Acquired with a NIDEK AFC-230 · image size 848x848 · DR severity per modified Davis staging
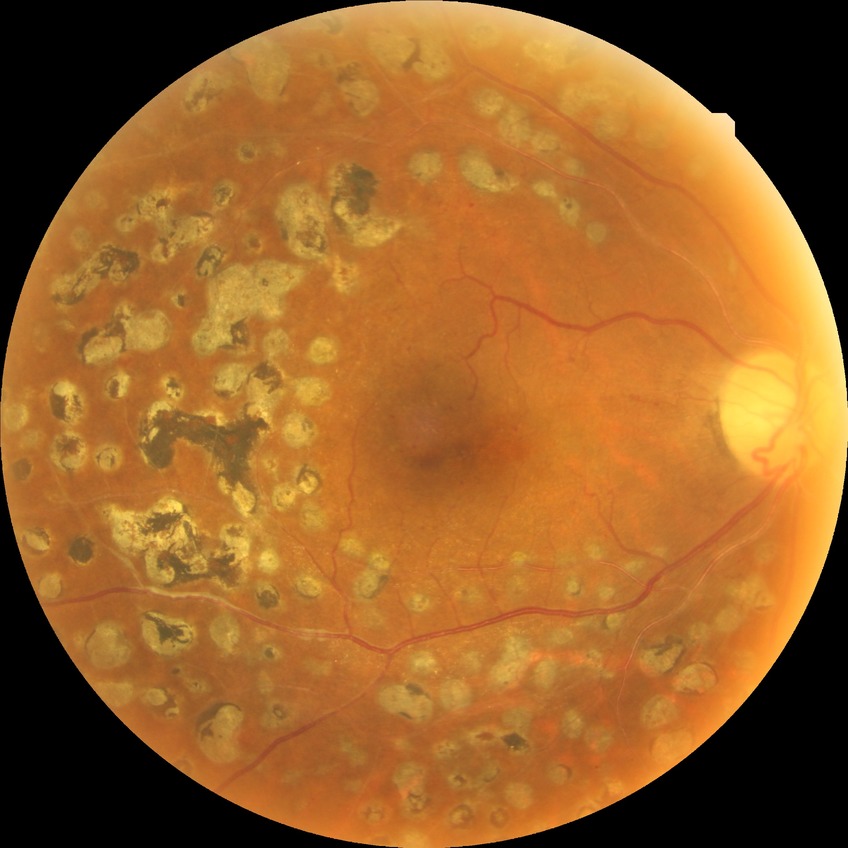
{"davis_grade": "PDR (proliferative diabetic retinopathy)"}